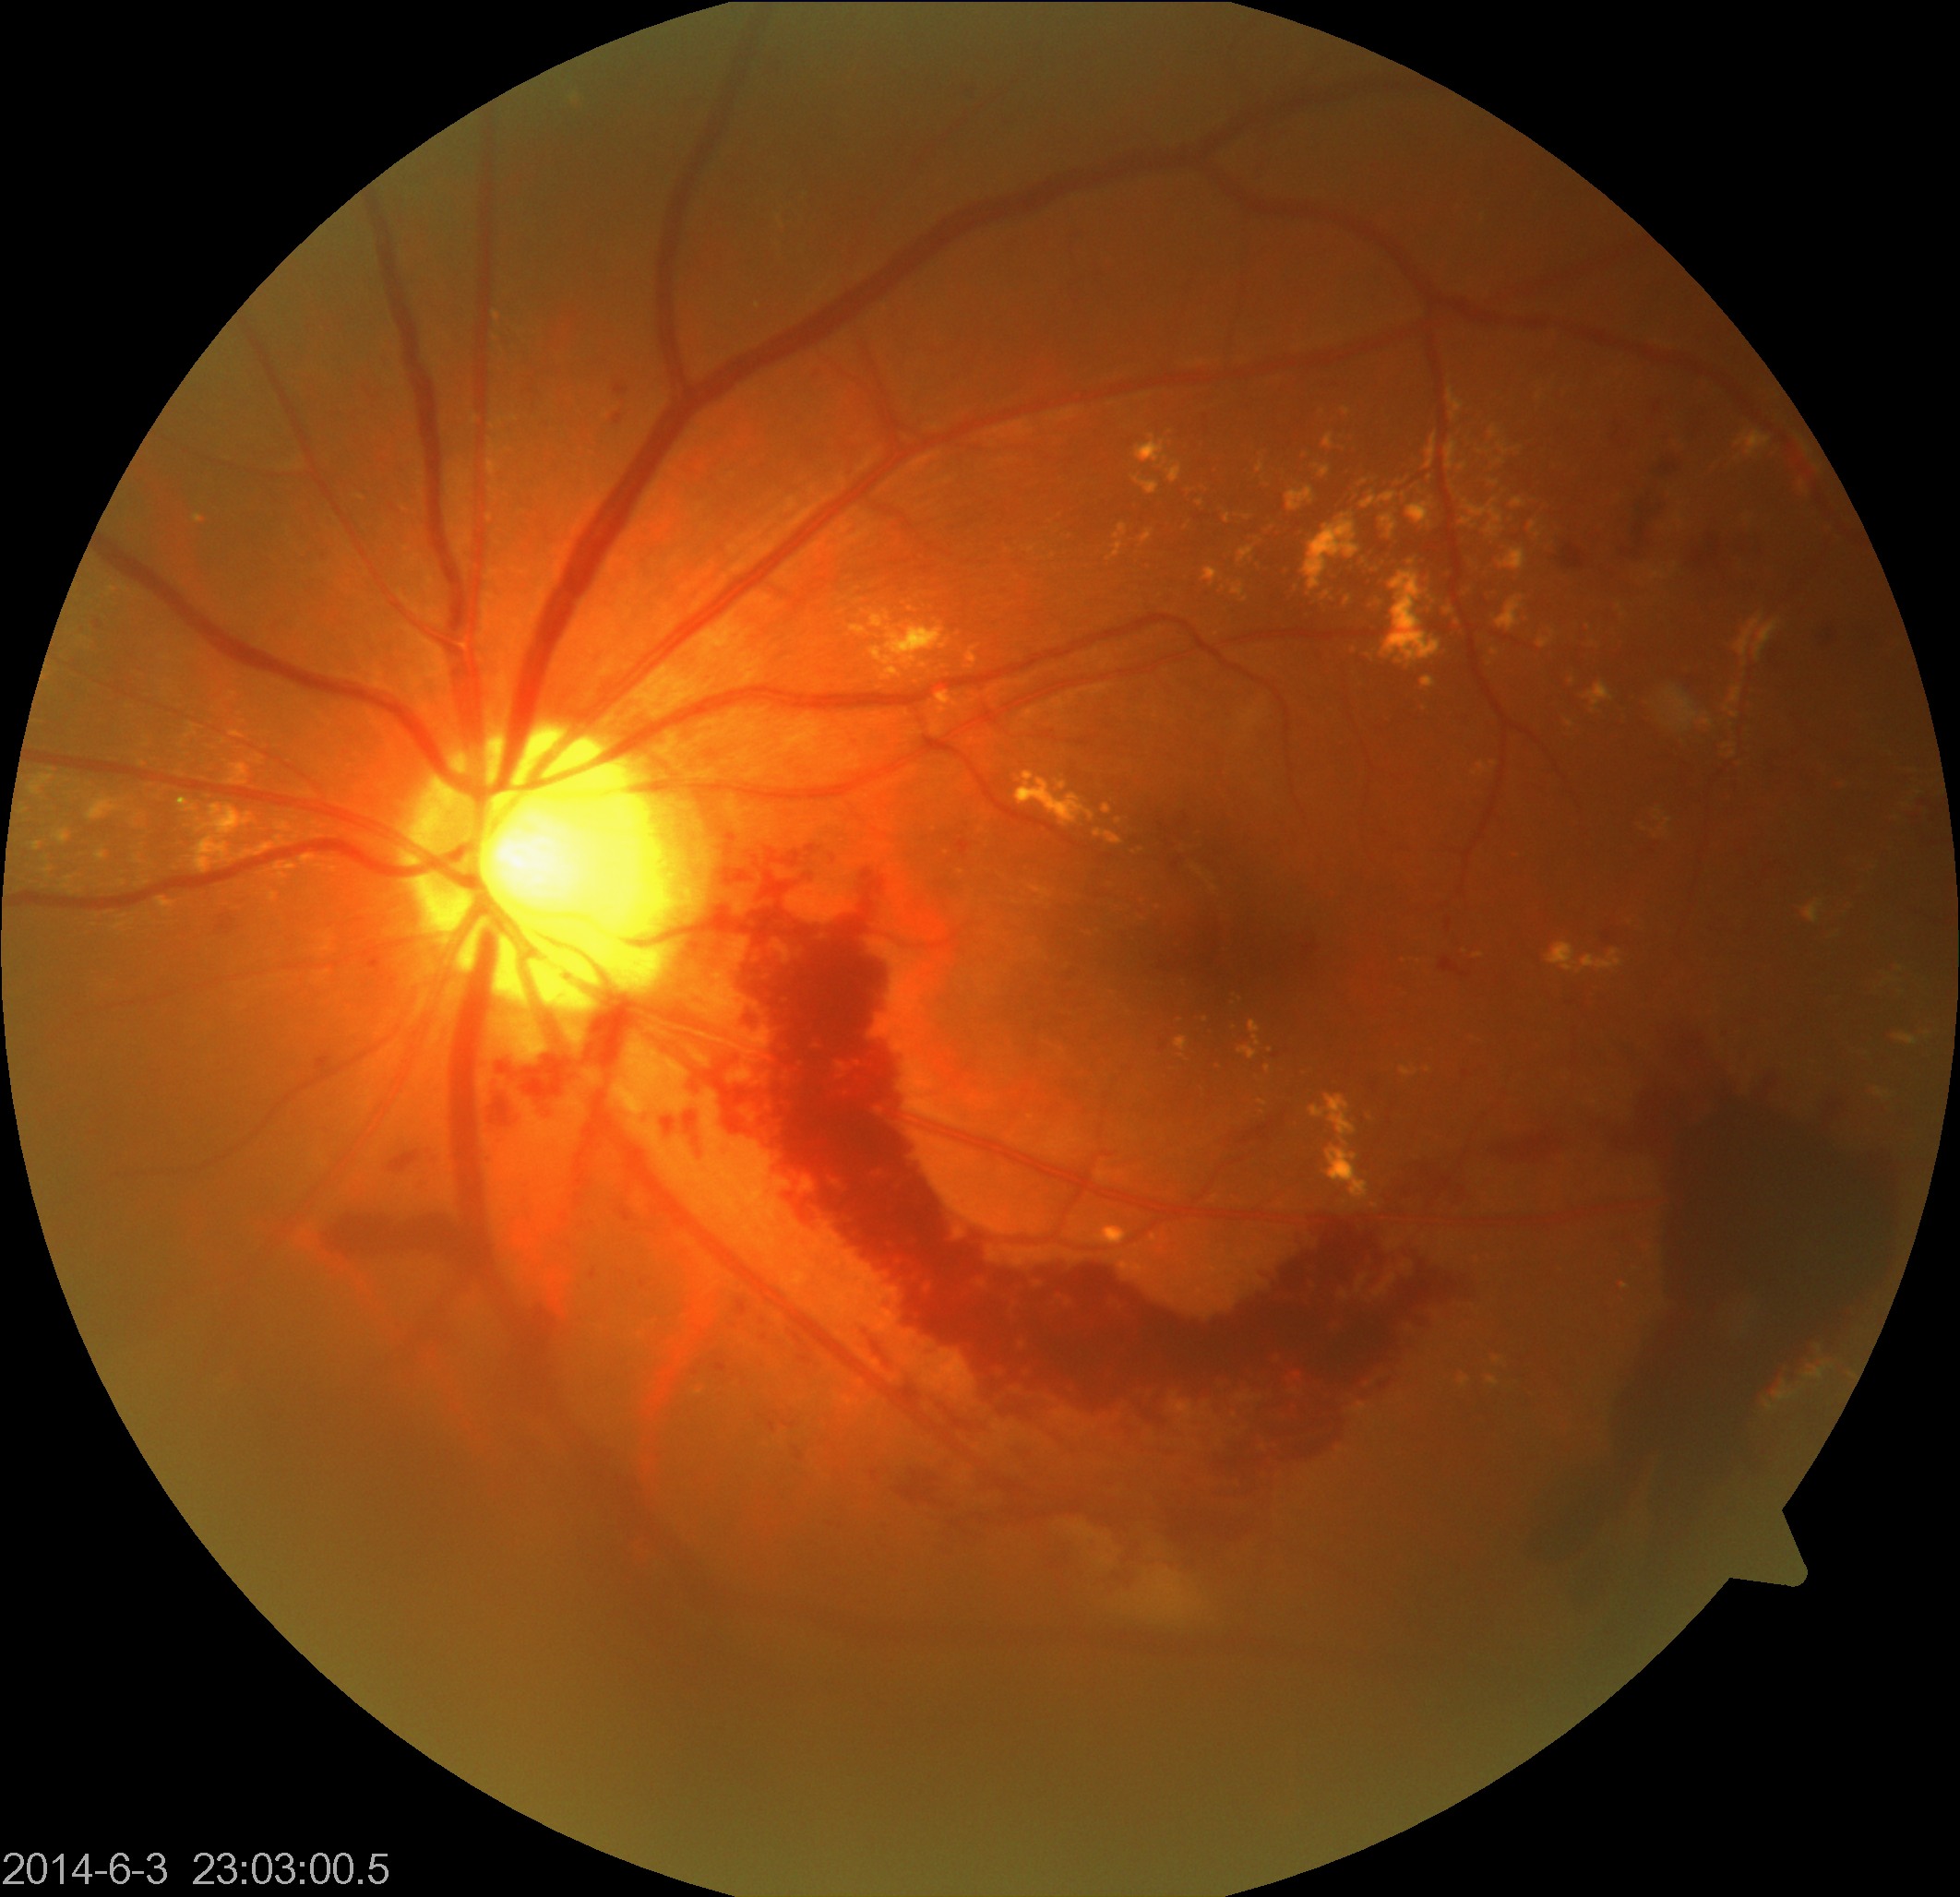 Findings: severe non-proliferative or proliferative diabetic retinopathy. Features include severe non-proliferative diabetic retinopathy or proliferative diabetic retinopathy with neovascularization or vitreous/preretinal hemorrhage.